45° field of view; 1536x1152.
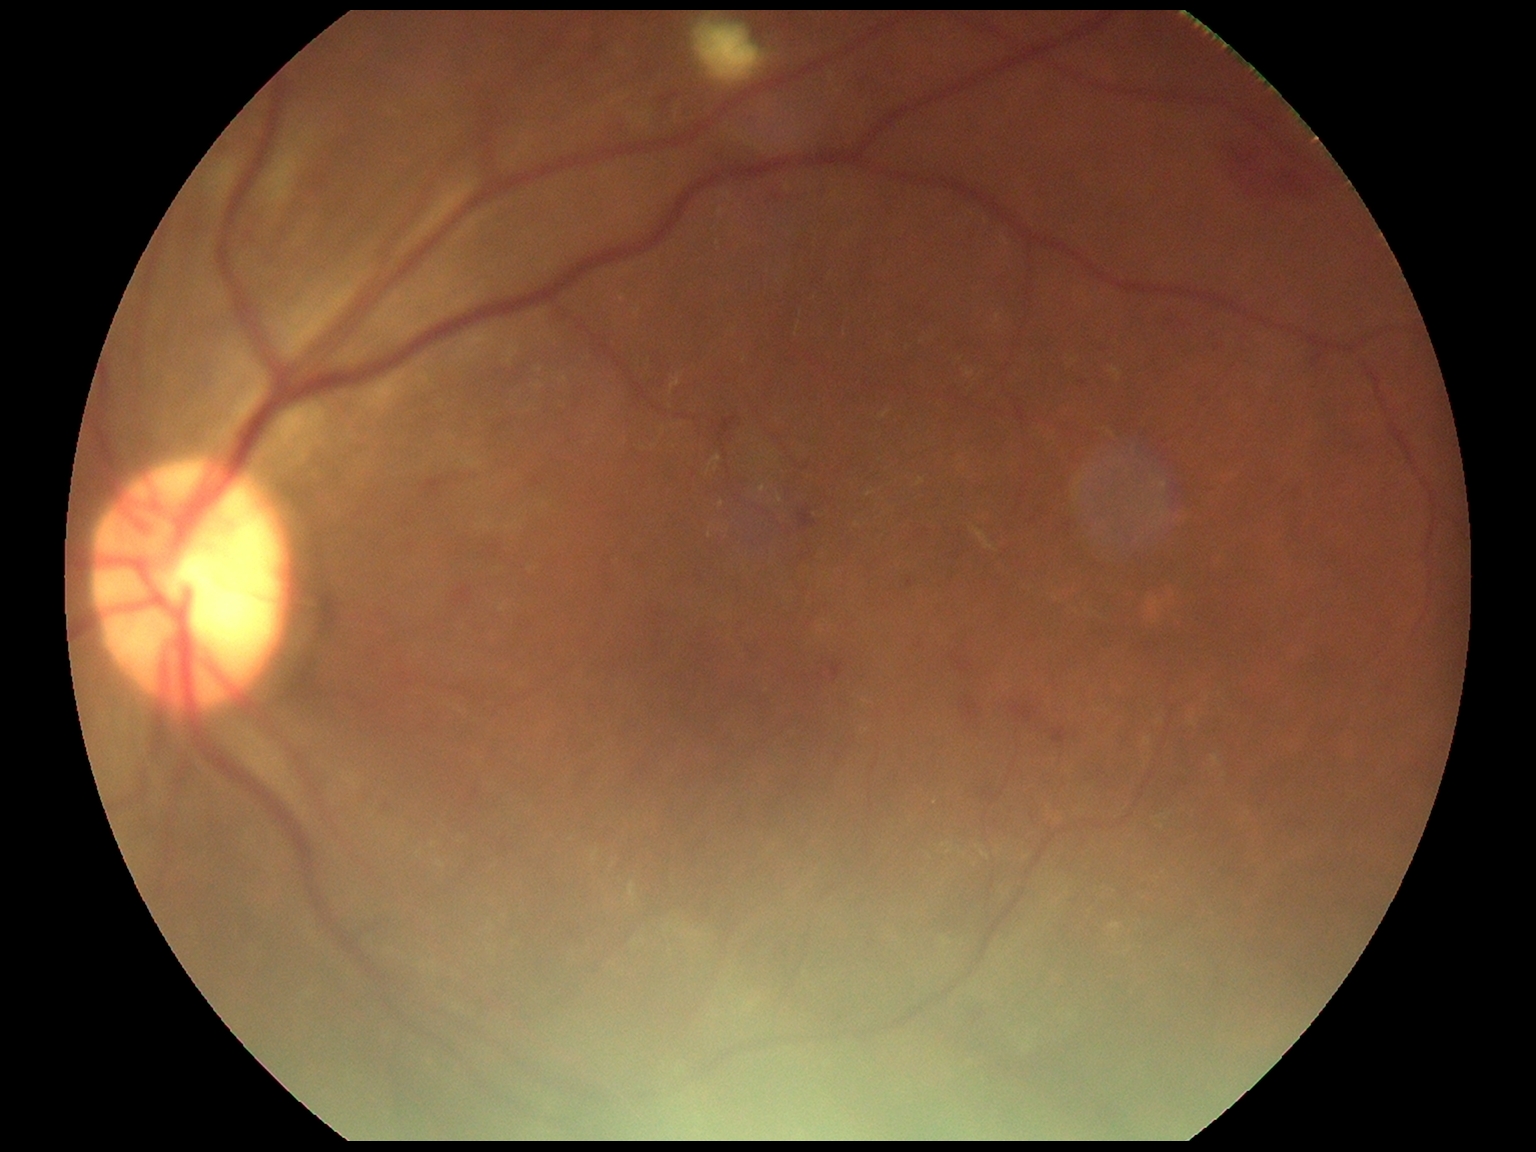
DR severity: grade 2 (moderate NPDR) — more than just microaneurysms but less than severe NPDR.